RetCam wide-field infant fundus image · acquired on the Clarity RetCam 3 · 640x480px:
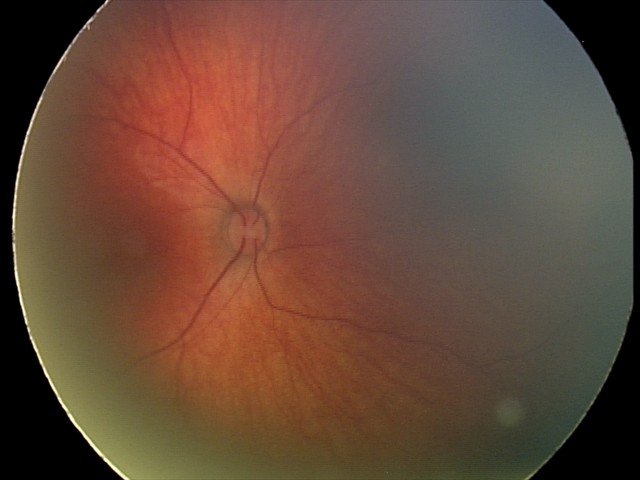 Assessment = retinal hemorrhages